Wide-field fundus image from infant ROP screening. 1440x1080. Captured with the Natus RetCam Envision (130° field of view): 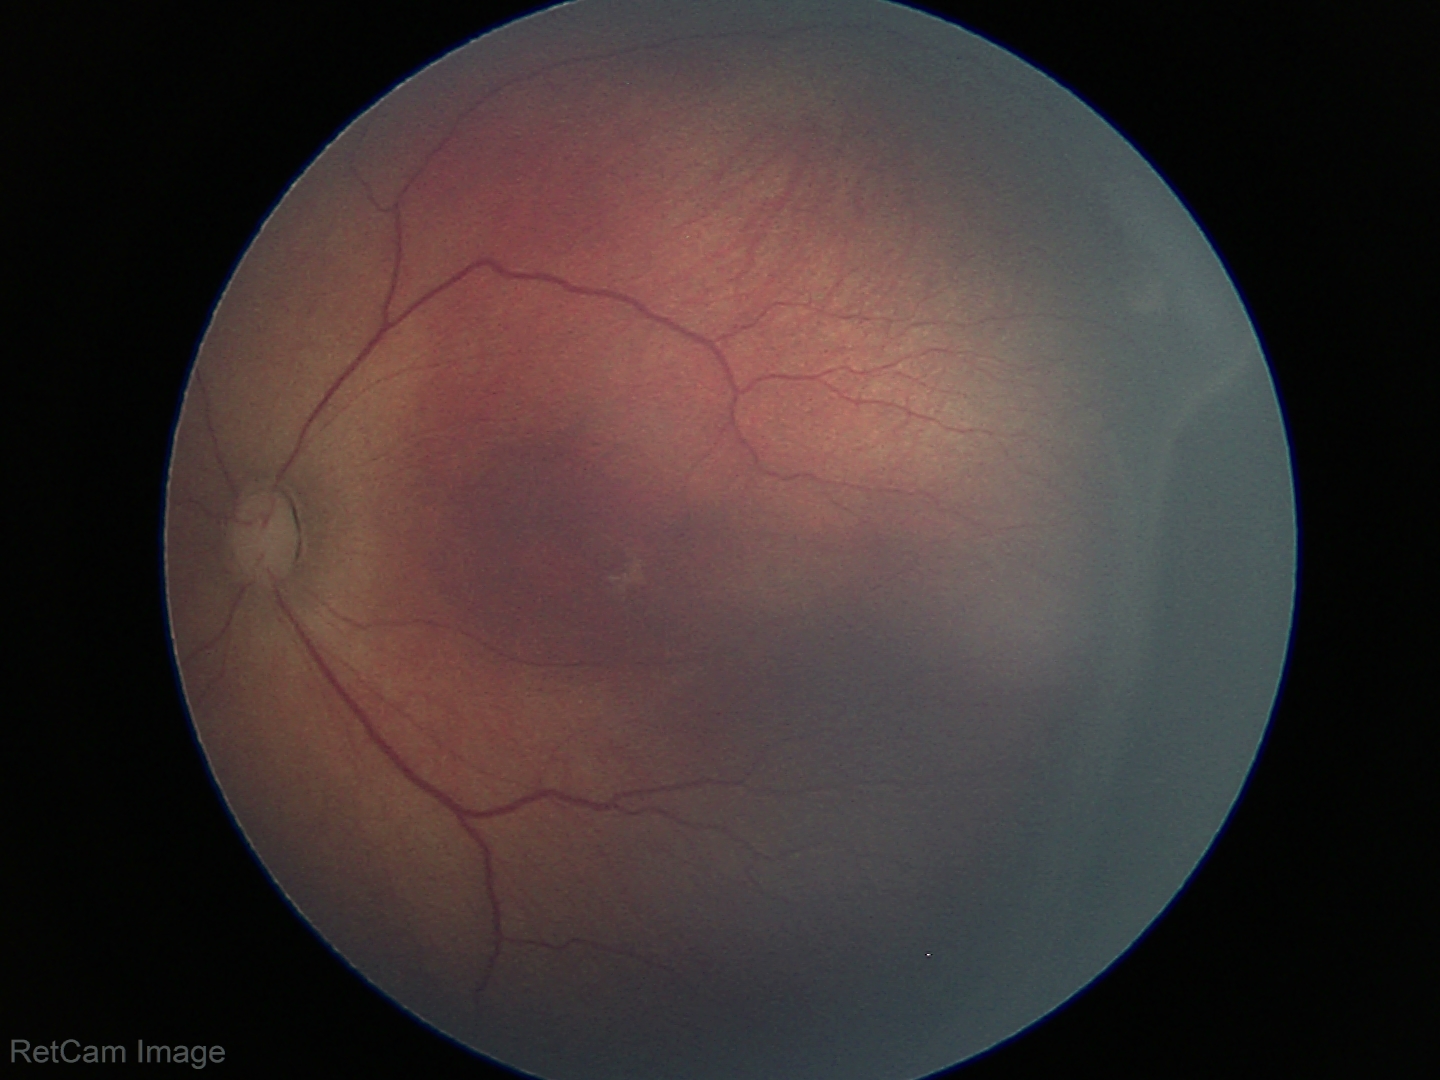 Examination diagnosed as ROP stage 3. No plus disease.